Image size 2352x1568; color fundus image; 45-degree field of view:
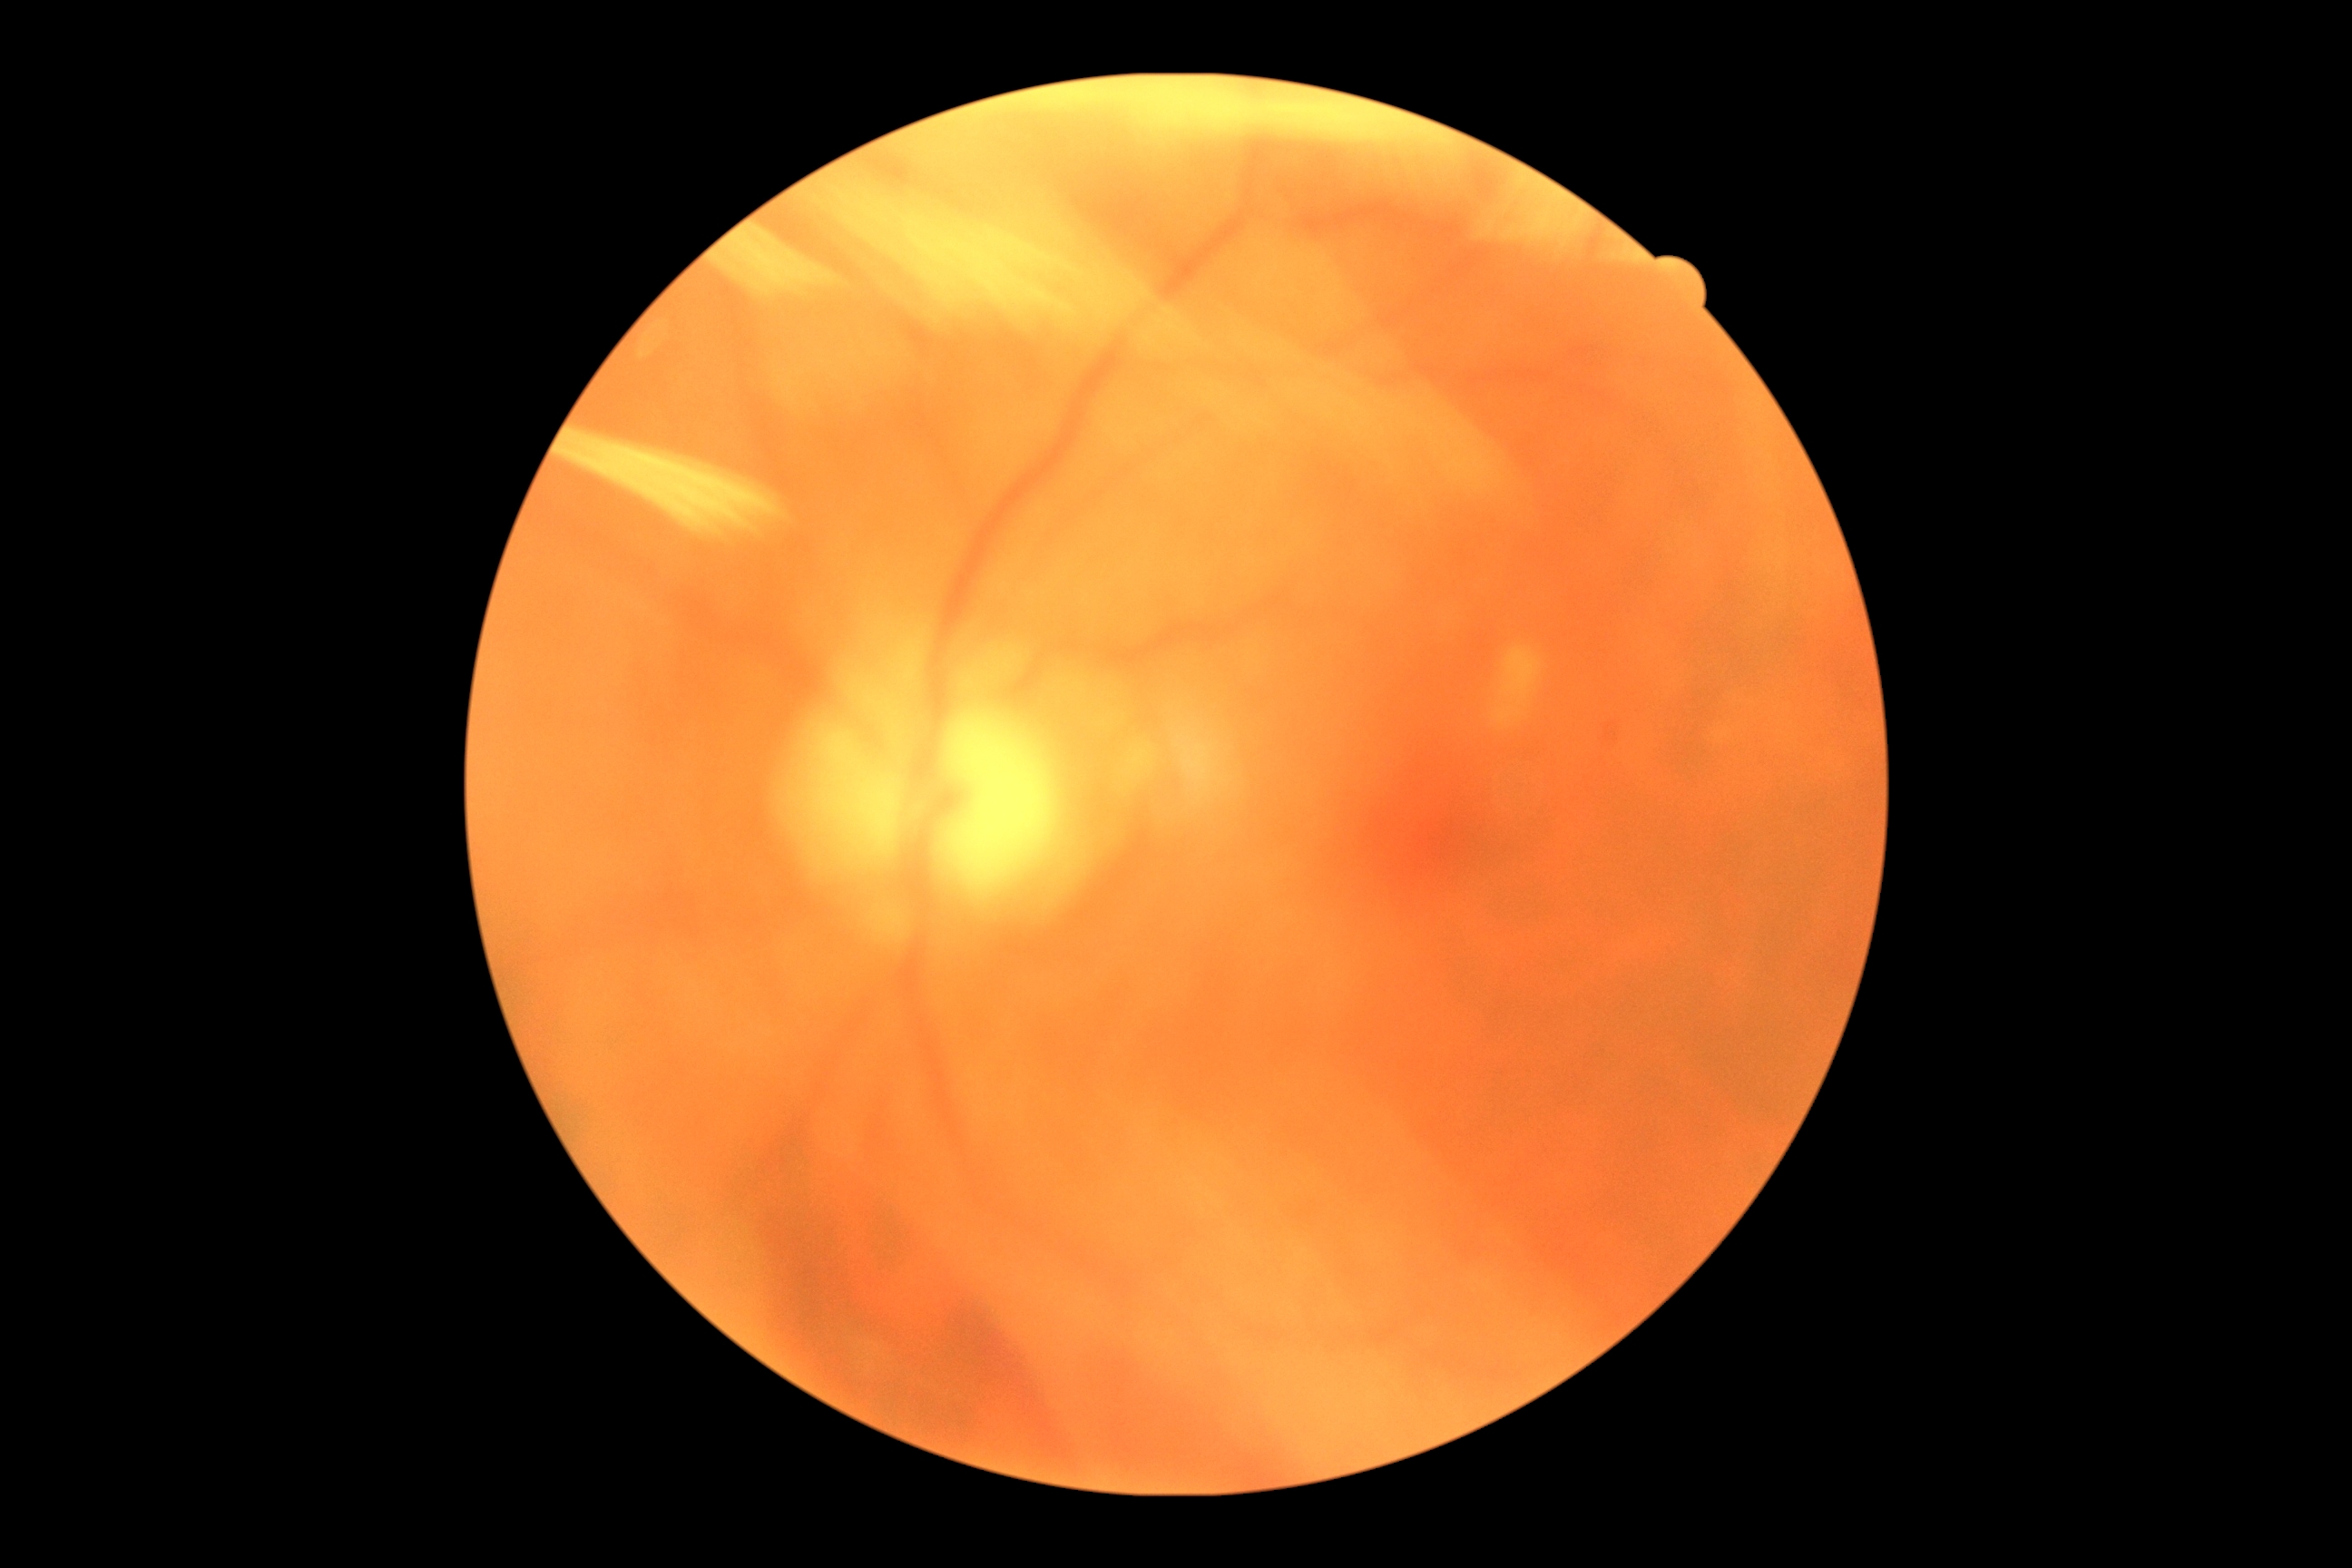 {"dr_grade": "ungradable due to poor image quality", "quality": "insufficient for DR assessment"}